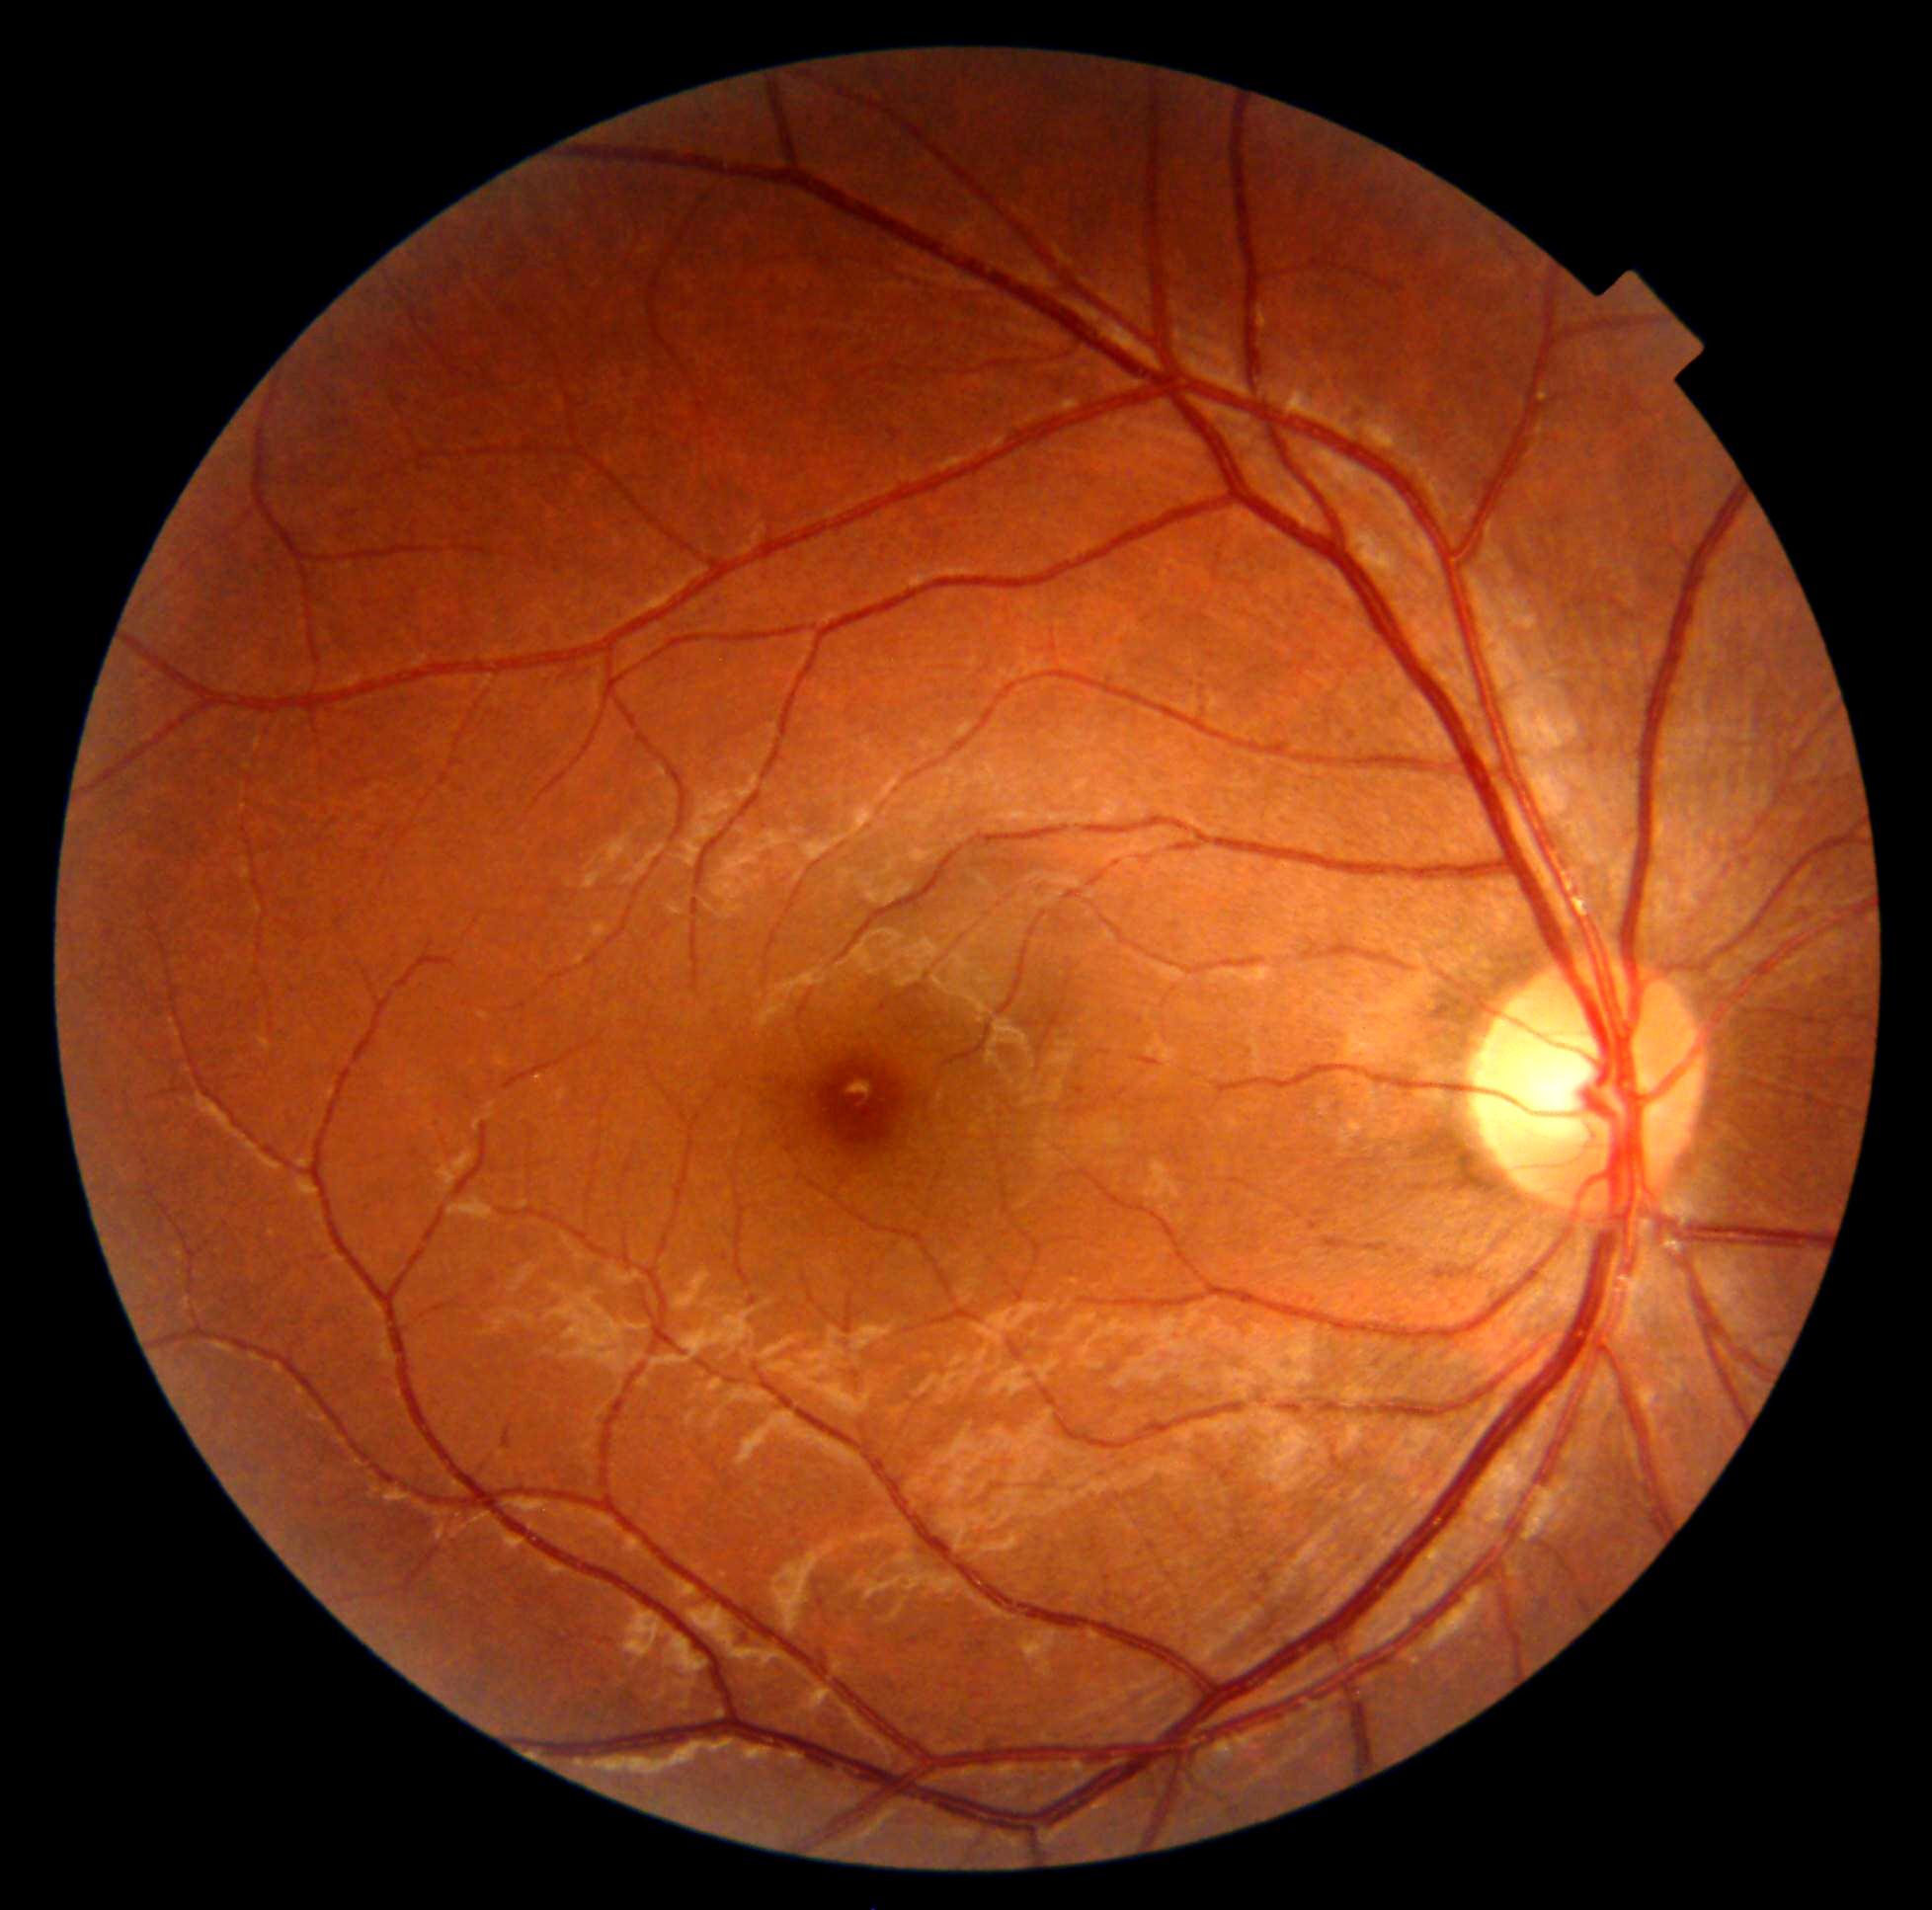

{
  "dr_grade": "0 (no apparent retinopathy)",
  "dr_impression": "negative for DR"
}